Infant wide-field fundus photograph · Phoenix ICON, 100° FOV · 1240 x 1240 pixels: 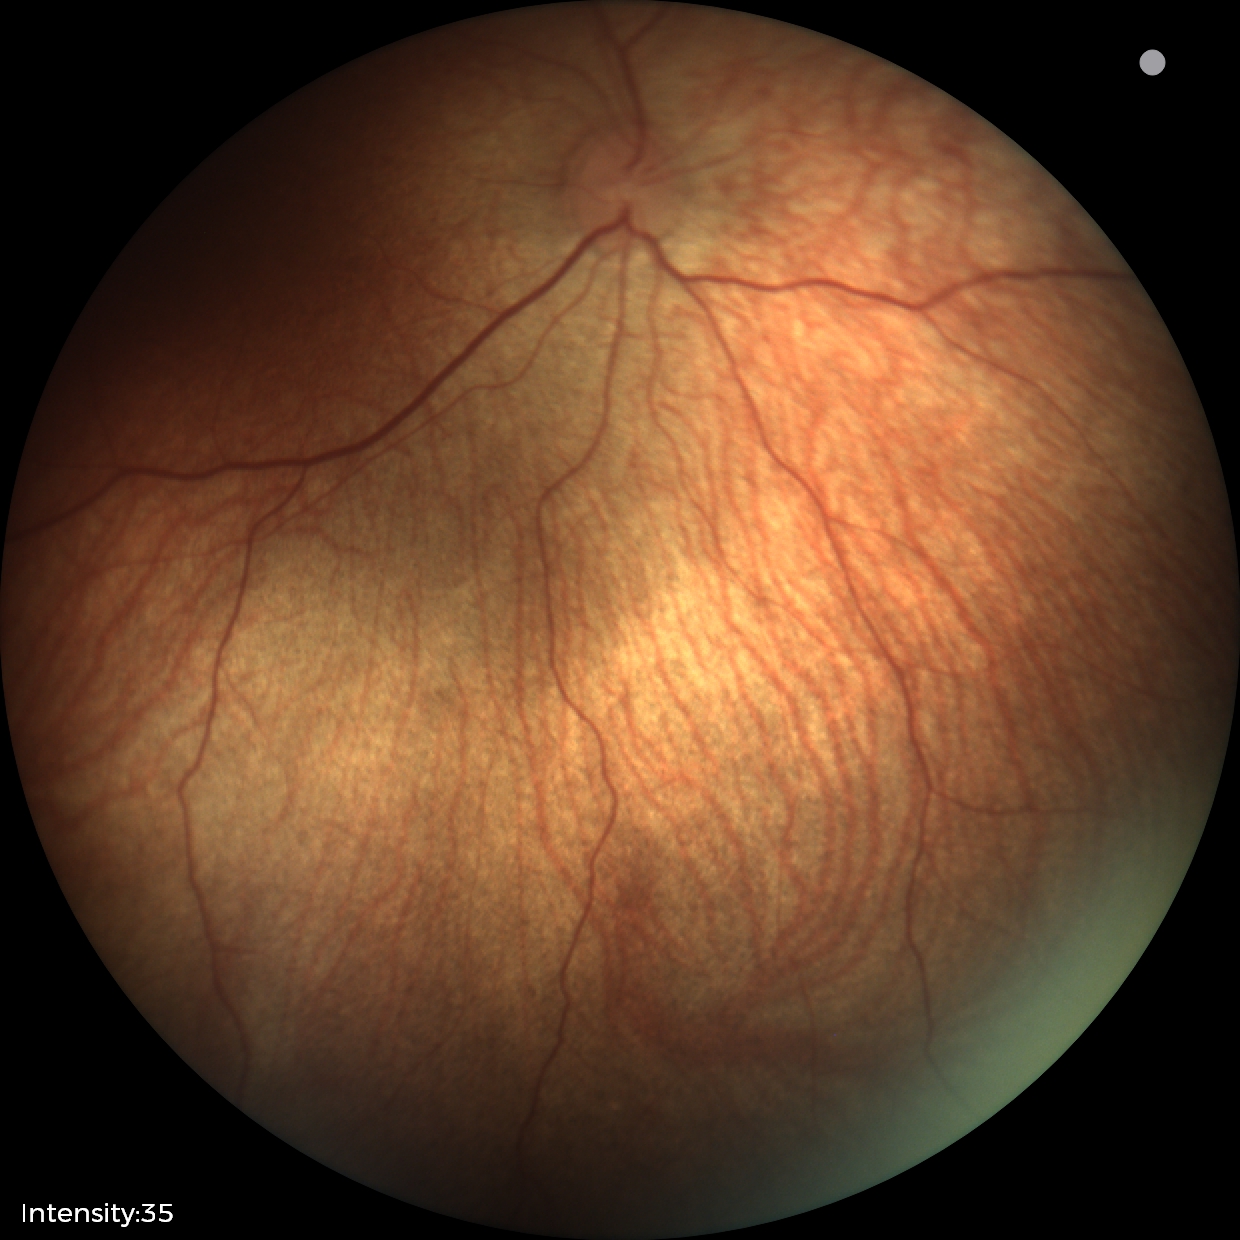 Assessment: no pathology identified.